45° field of view; retinal fundus photograph; 2352x1568px:
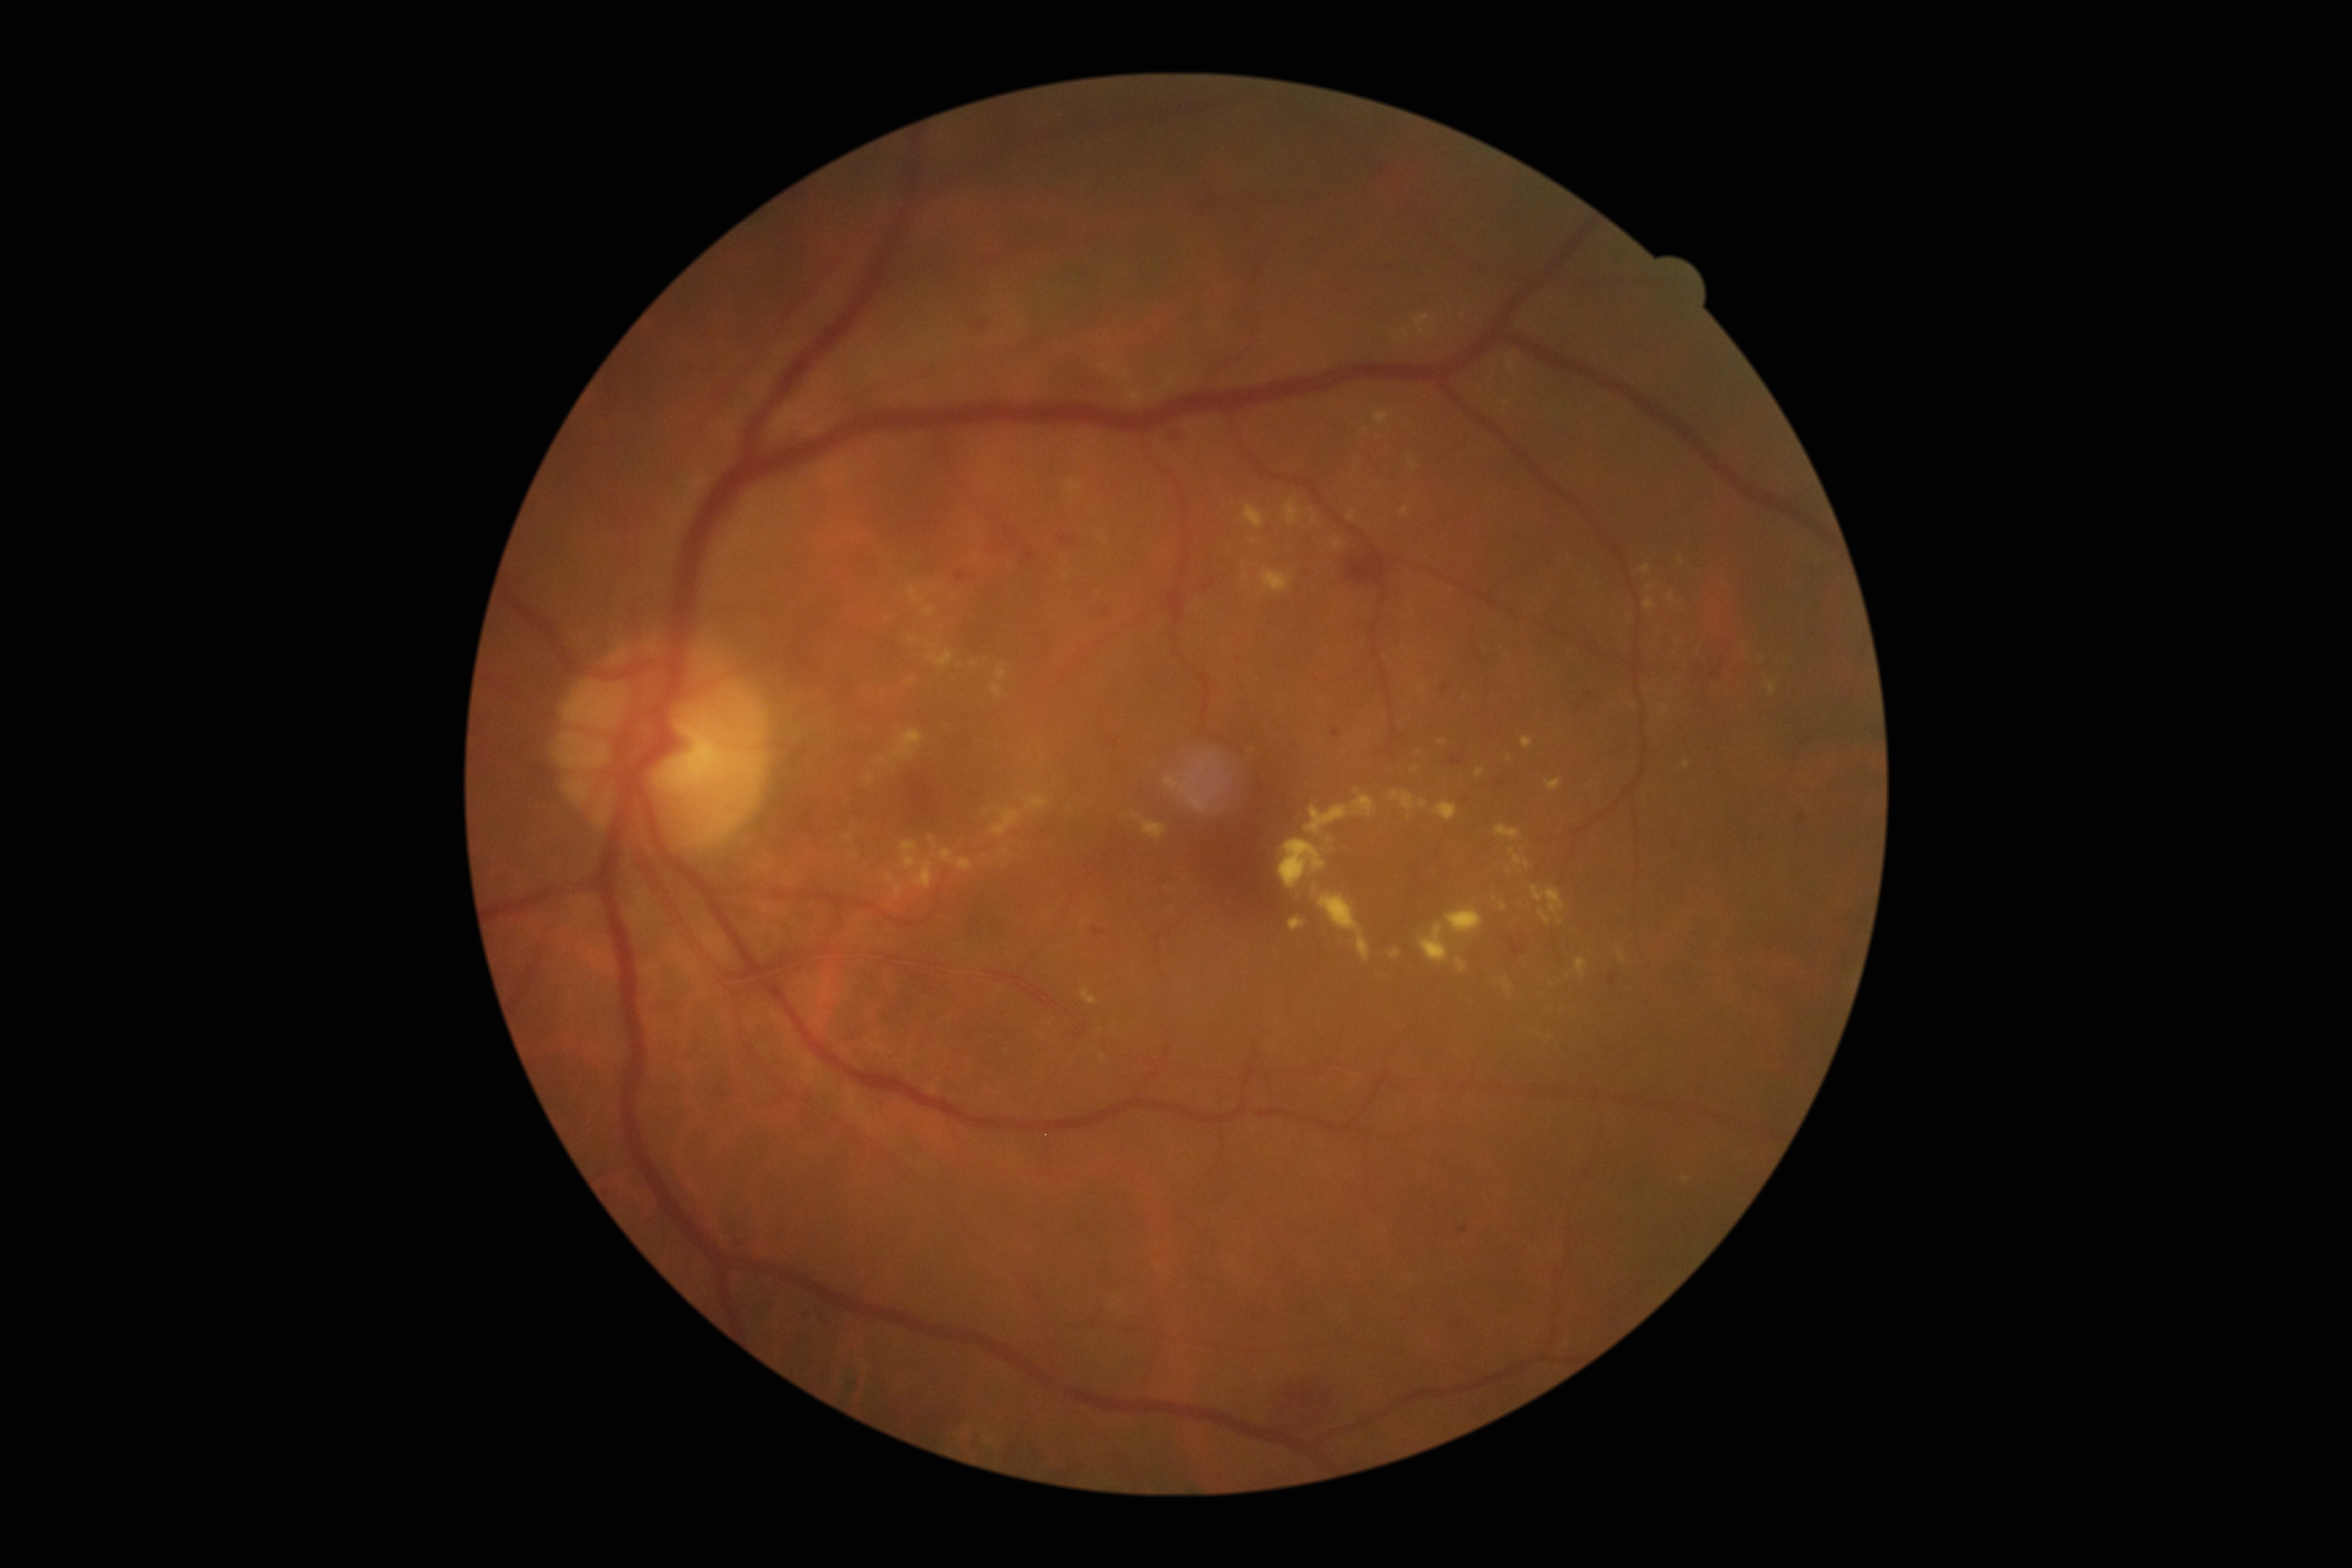 DR severity: 2/4 — more than just microaneurysms but less than severe NPDR.